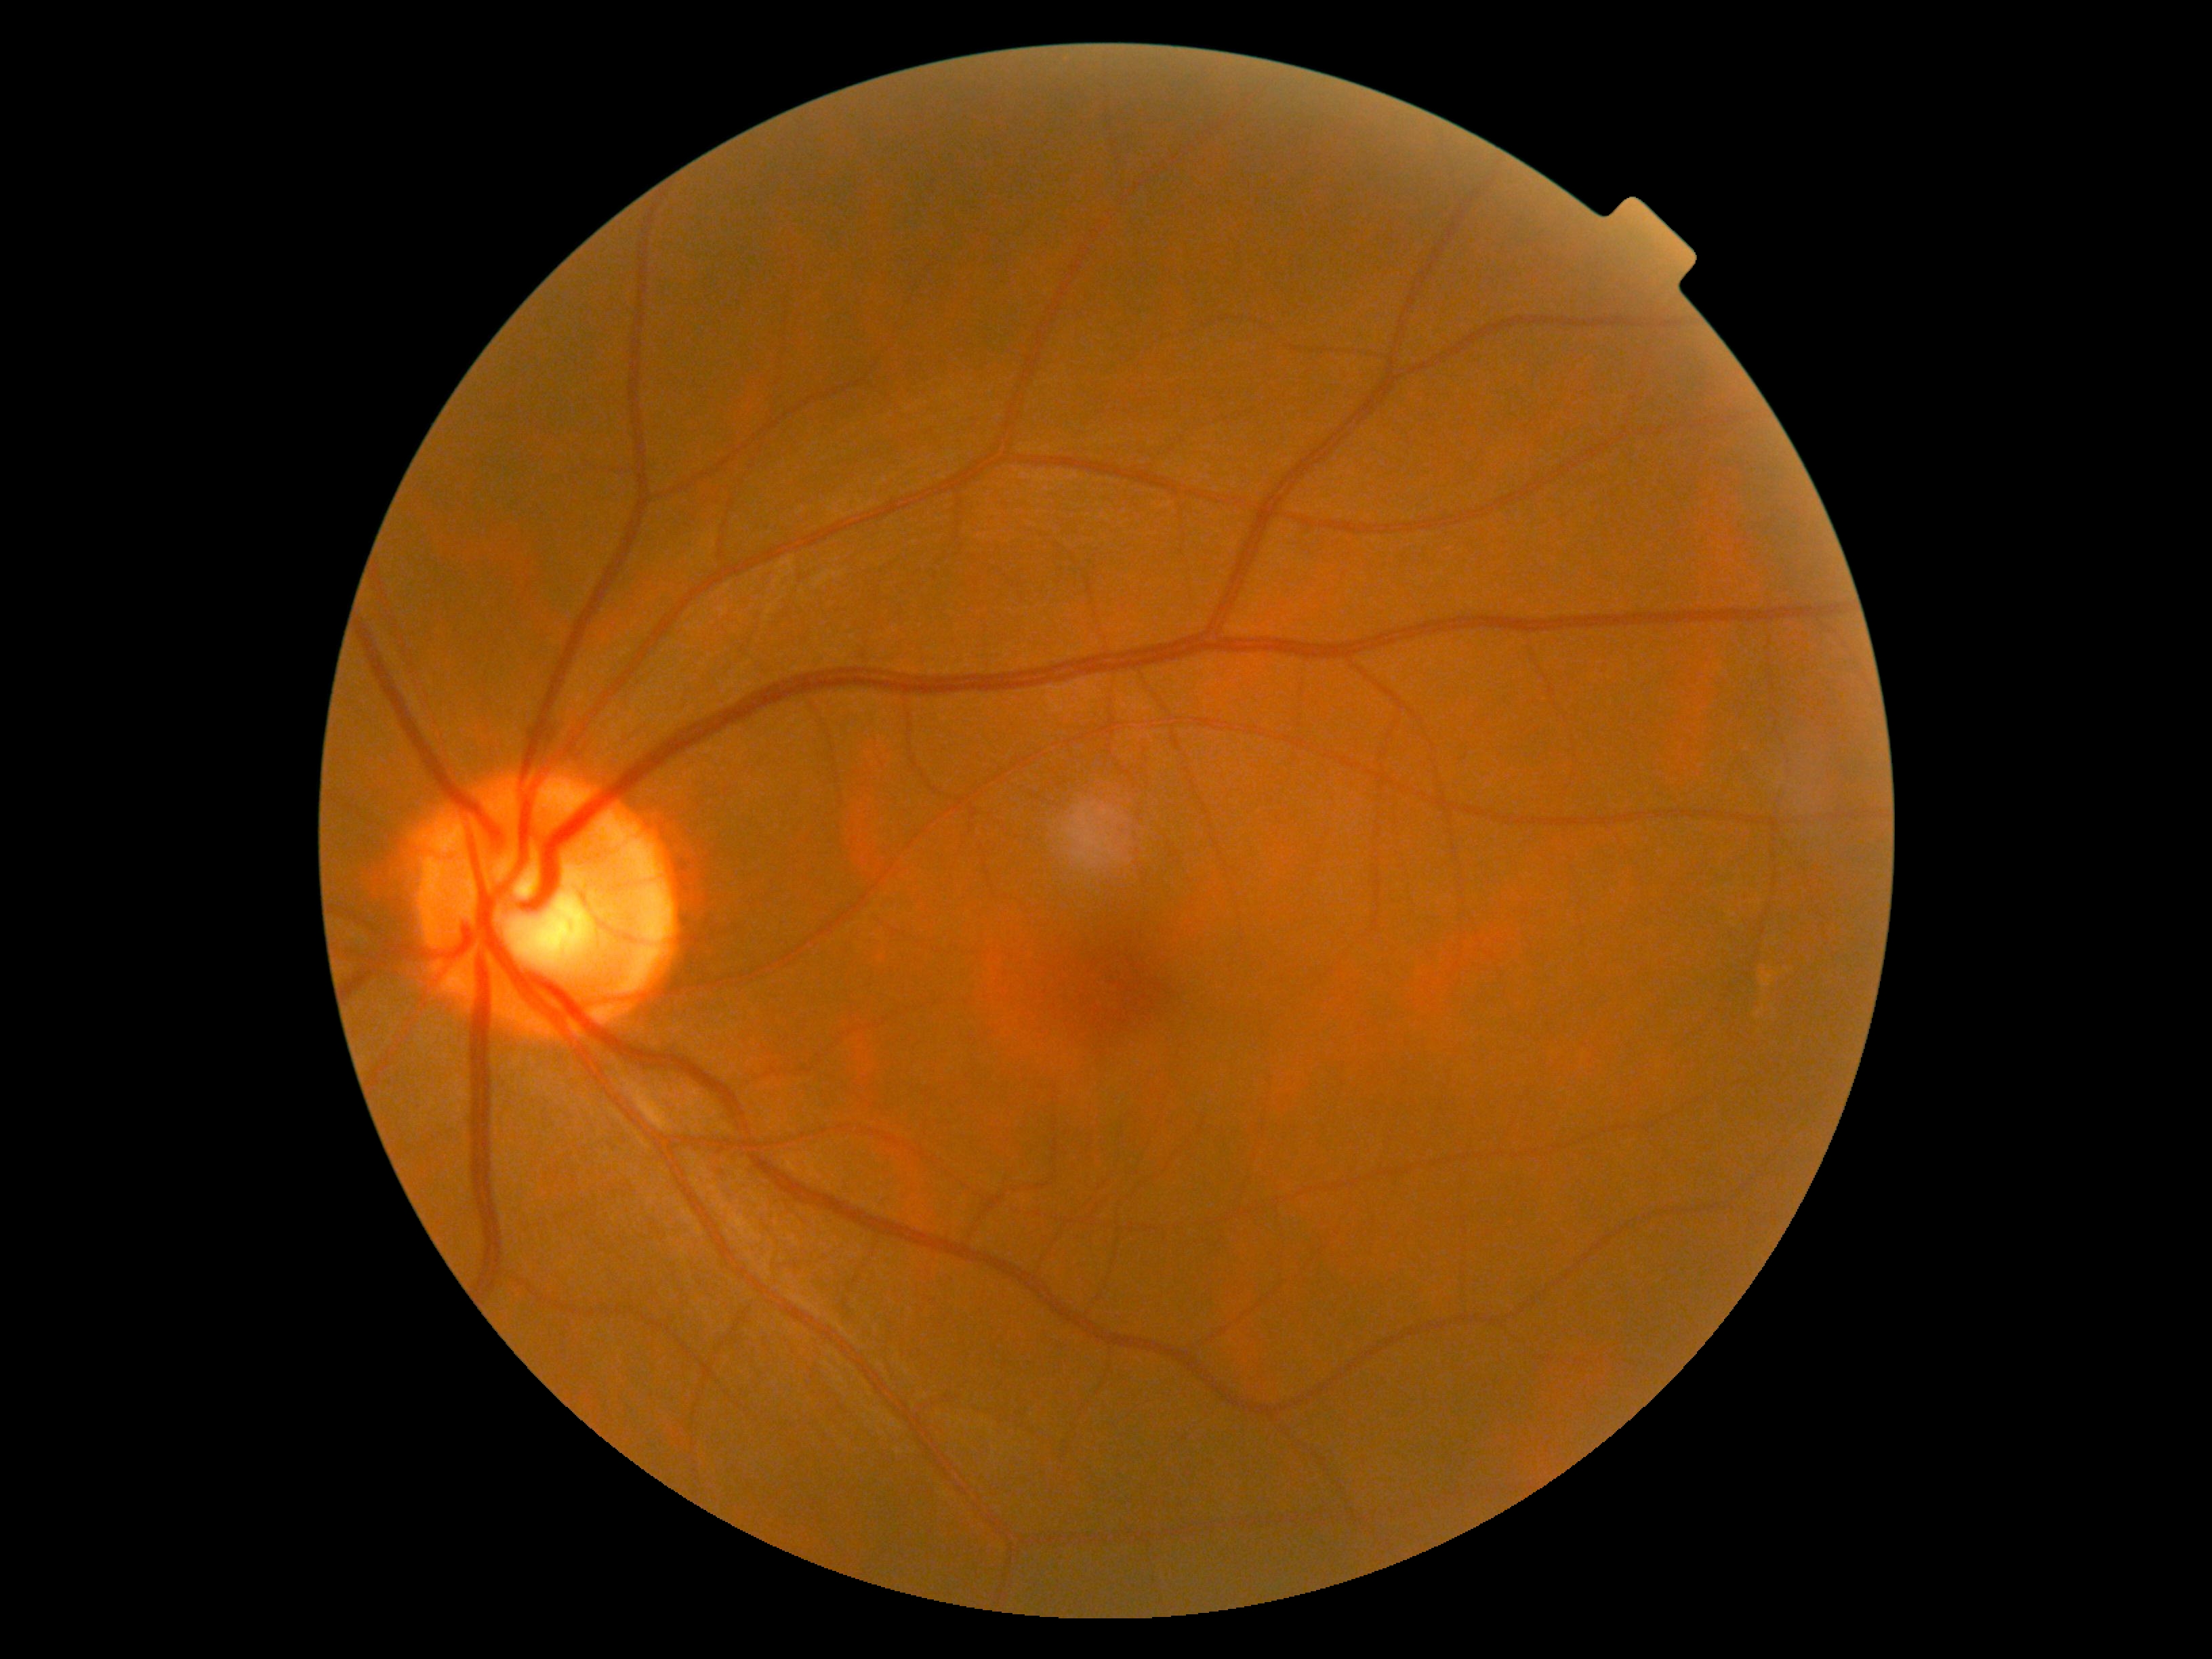

Findings:
• retinopathy grade: no apparent diabetic retinopathy (0)
• DR impression: no DR findings